FOV: 45 degrees; 2352x1568: 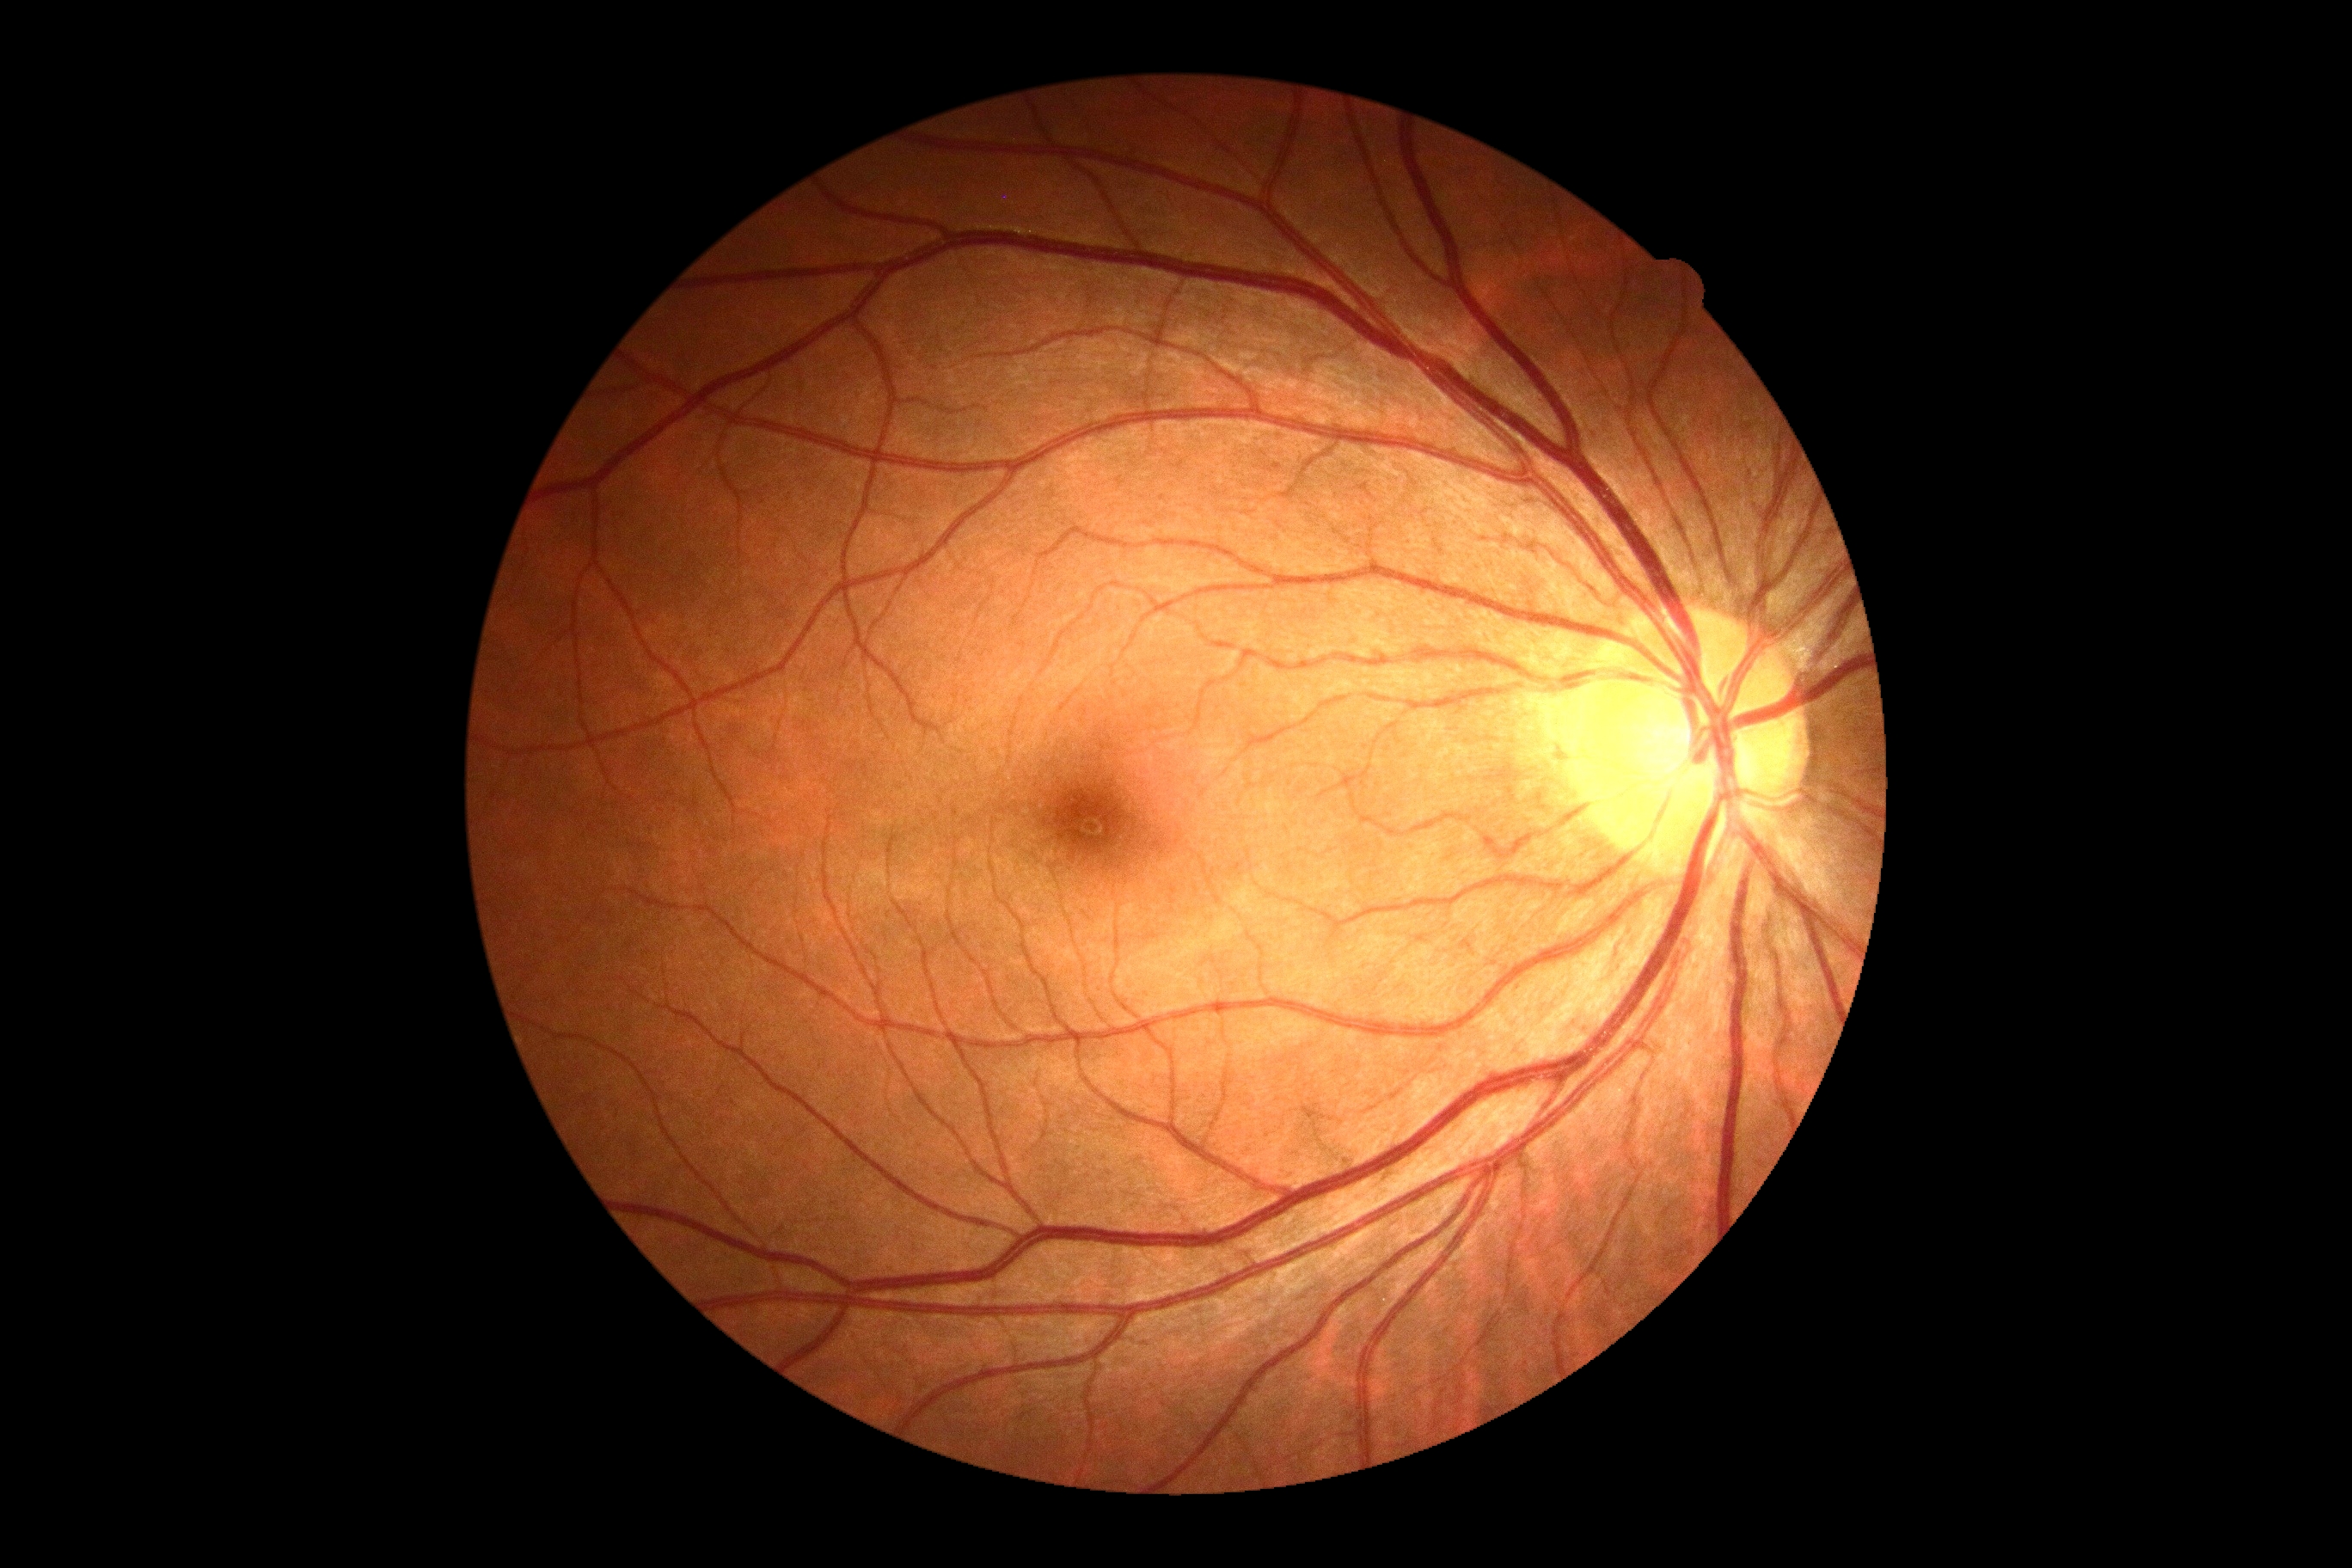 No signs of diabetic retinopathy. Diabetic retinopathy is 0/4 — no visible signs of diabetic retinopathy.